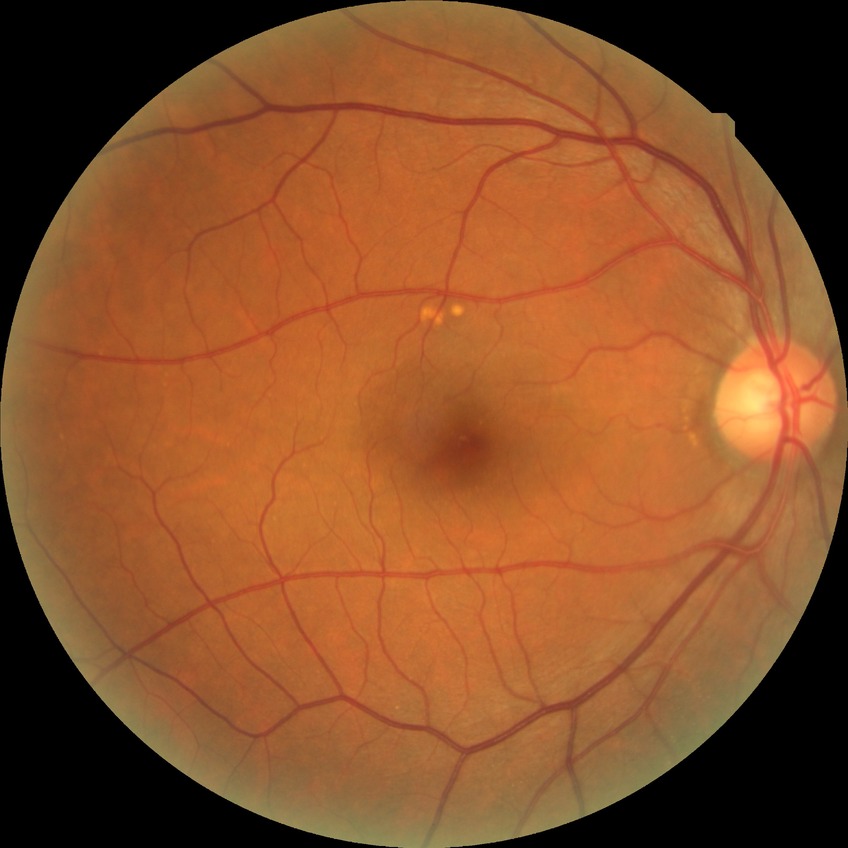
{
  "davis_grade": "no diabetic retinopathy"
}